Without pupil dilation · image size 848x848.
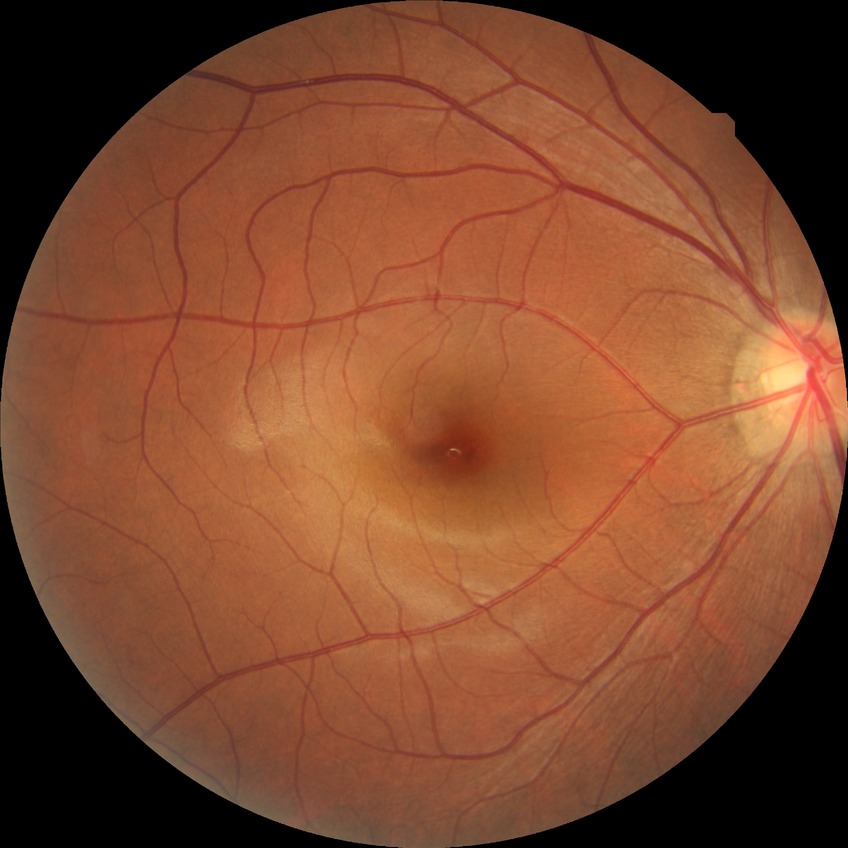 Diabetic retinopathy (DR) is no diabetic retinopathy (NDR).